Wide-field fundus image from infant ROP screening. 1440x1080:
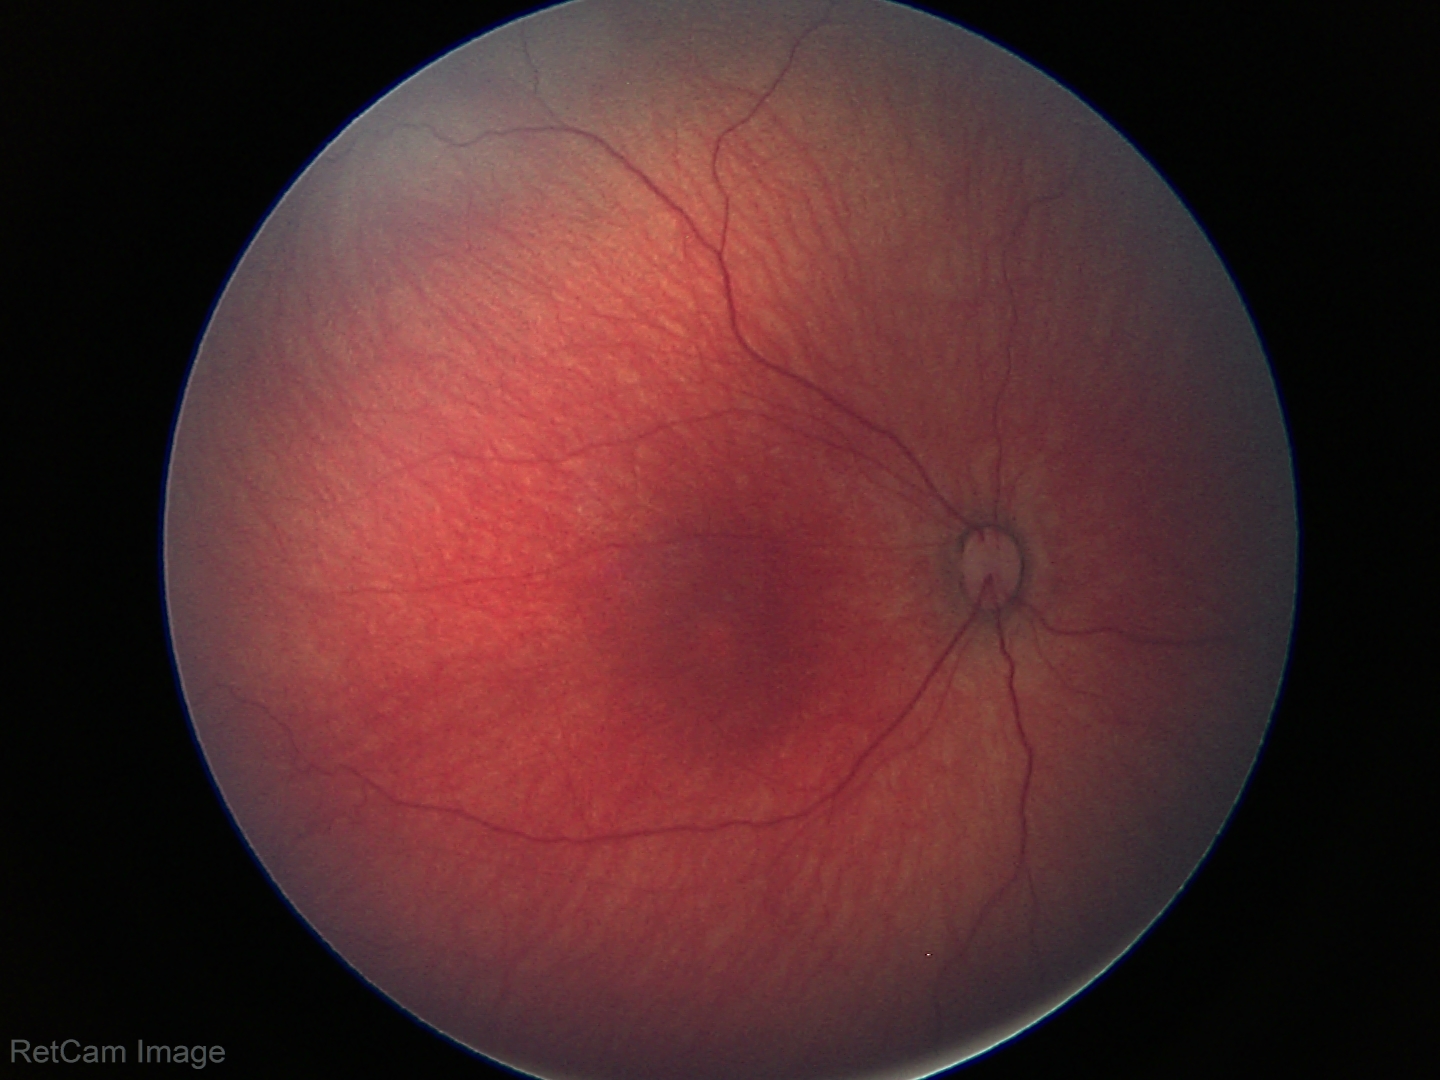
Screening examination diagnosed as physiological.